DR severity per modified Davis staging:
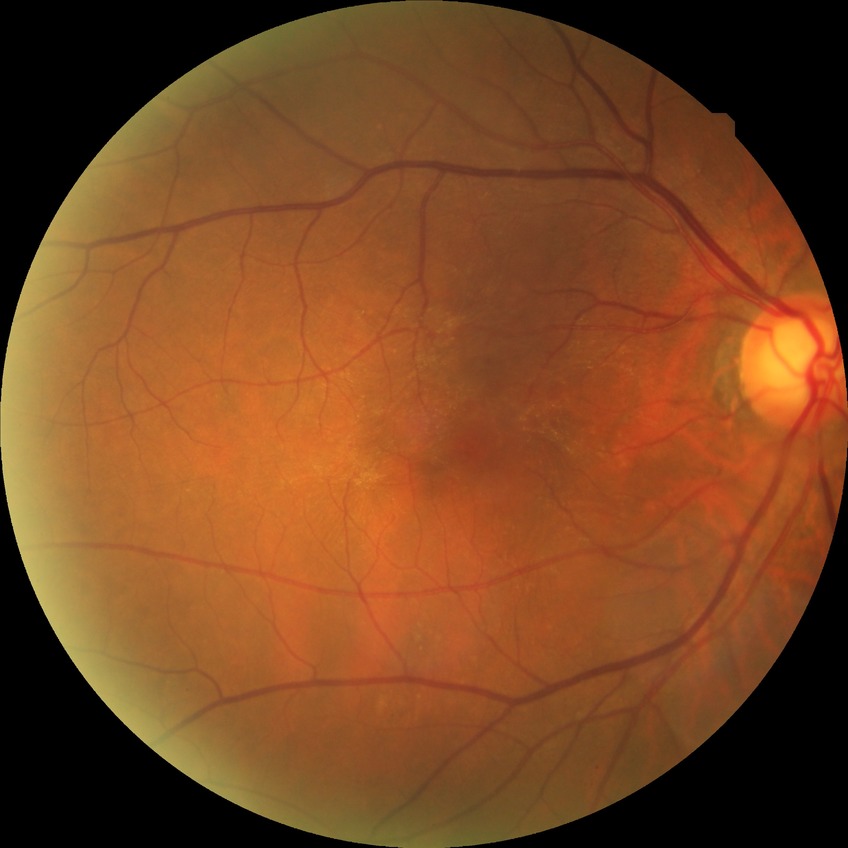
Diabetic retinopathy (DR): no diabetic retinopathy (NDR).